2352 by 1568 pixels · FOV: 45 degrees · fundus photo — 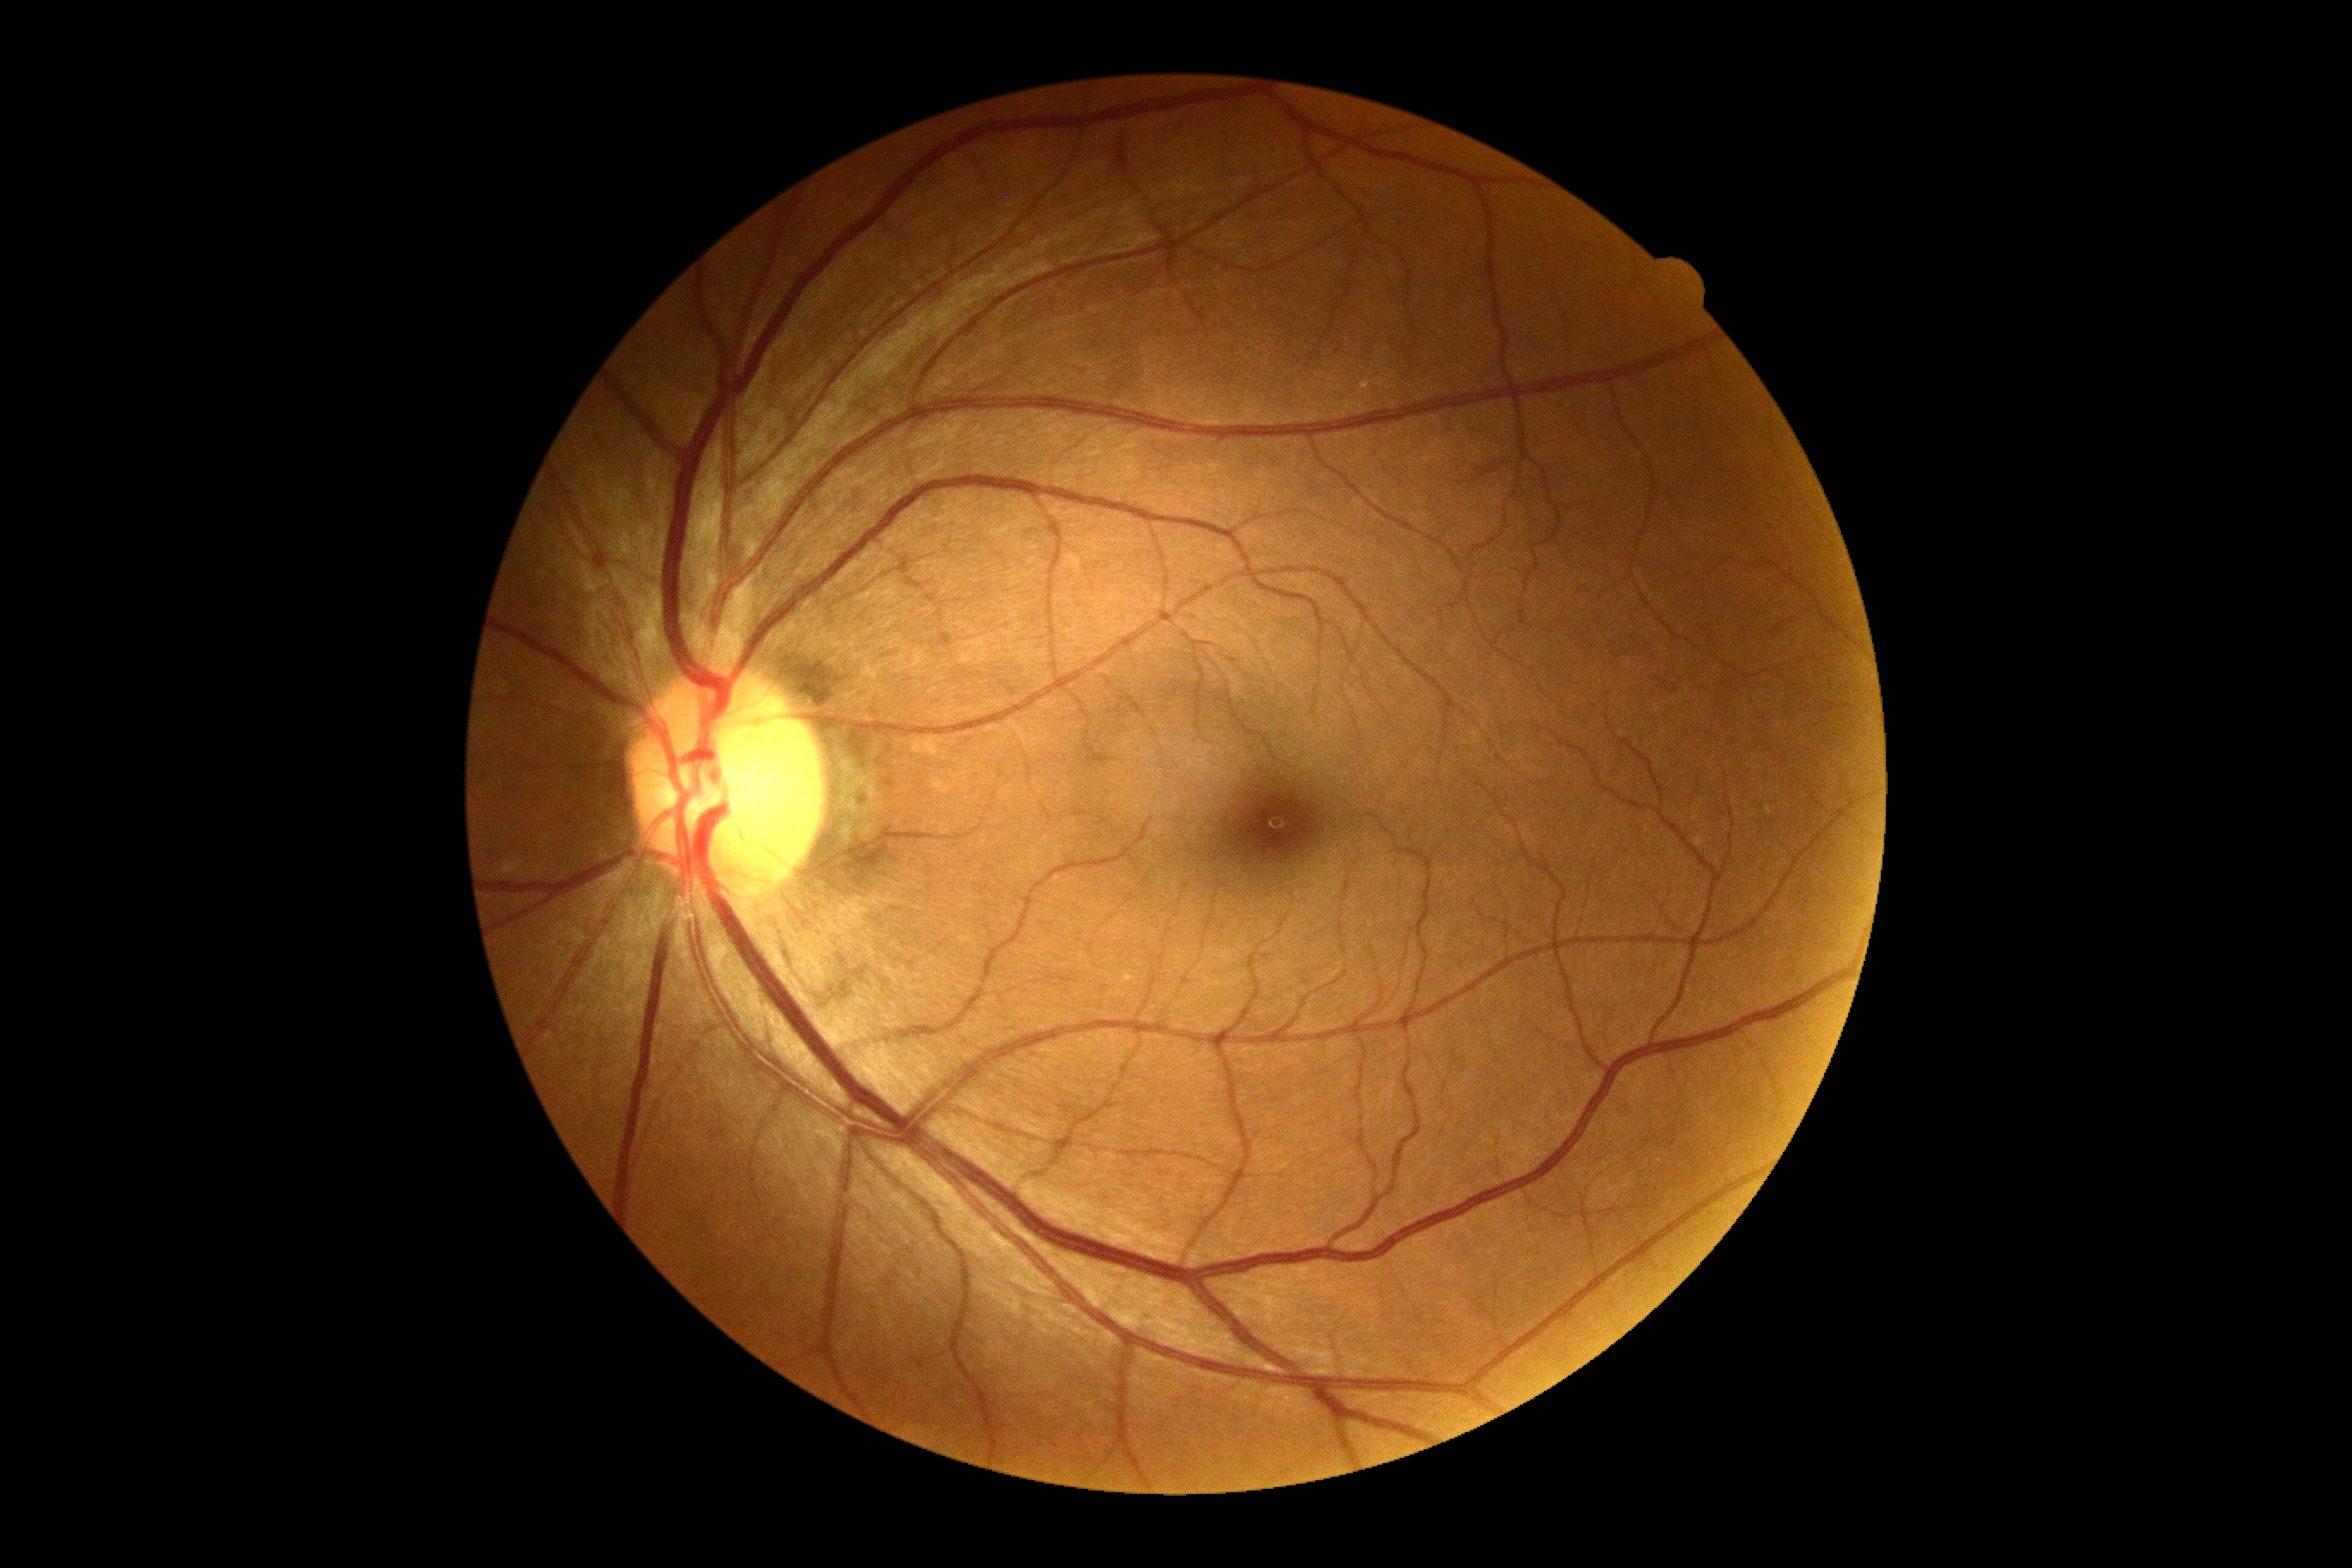

DR: no apparent diabetic retinopathy (grade 0) — no visible signs of diabetic retinopathy.